Without pupil dilation · 45-degree field of view.
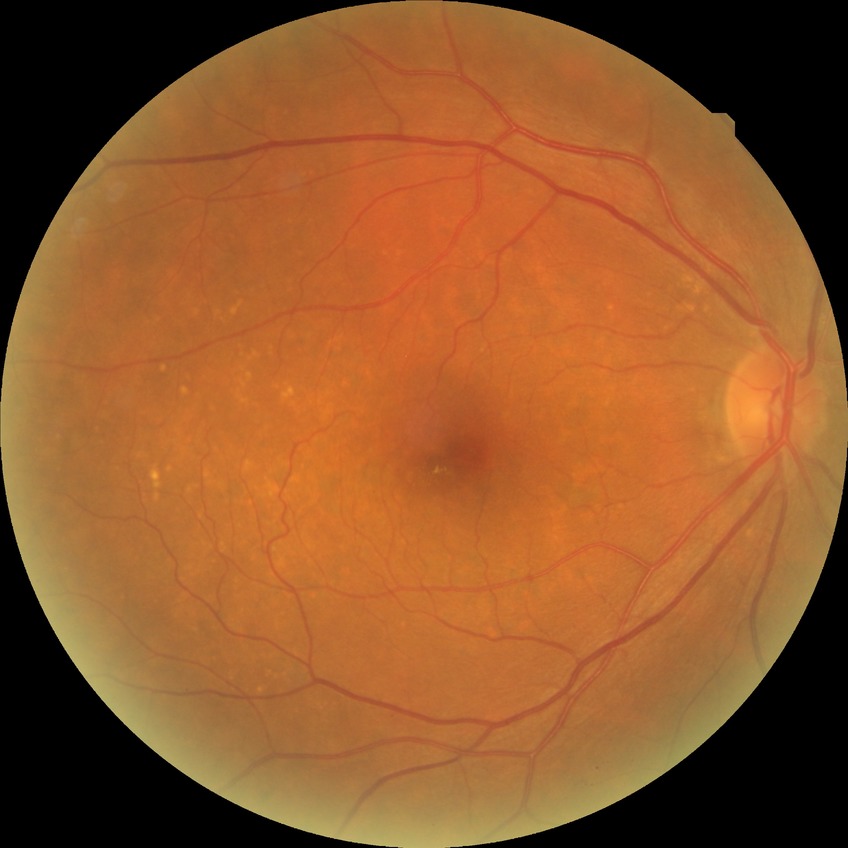

Diabetic retinopathy (DR) is NDR (no diabetic retinopathy).